DR severity per modified Davis staging; nonmydriatic
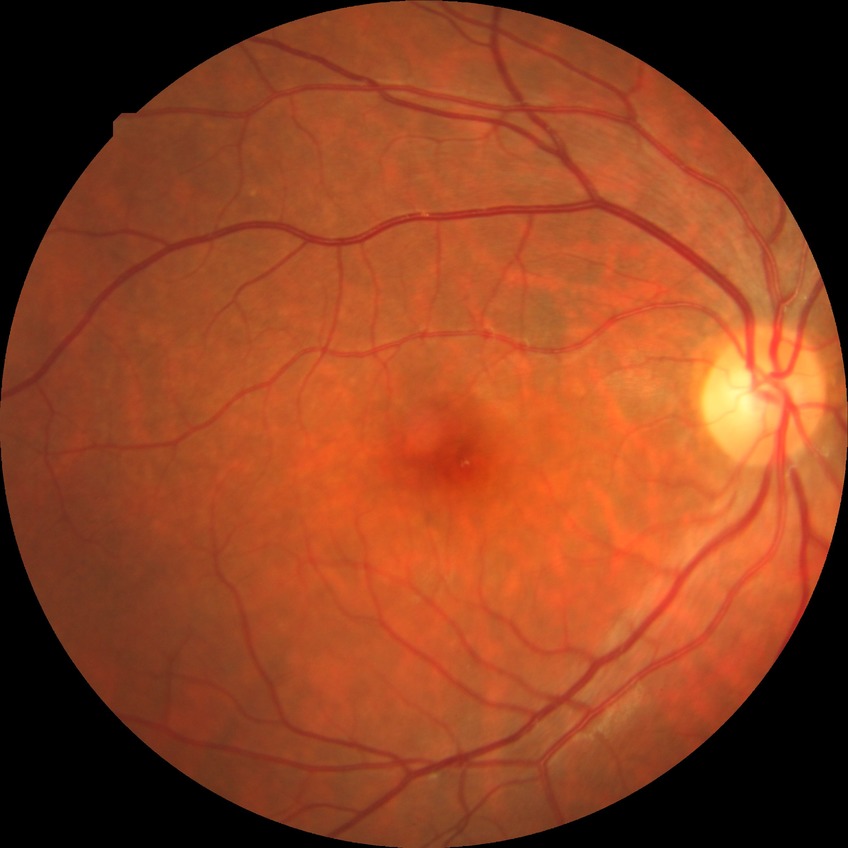 Retinopathy grade: no diabetic retinopathy.